DR severity per modified Davis staging · 45-degree field of view · nonmydriatic · CFP
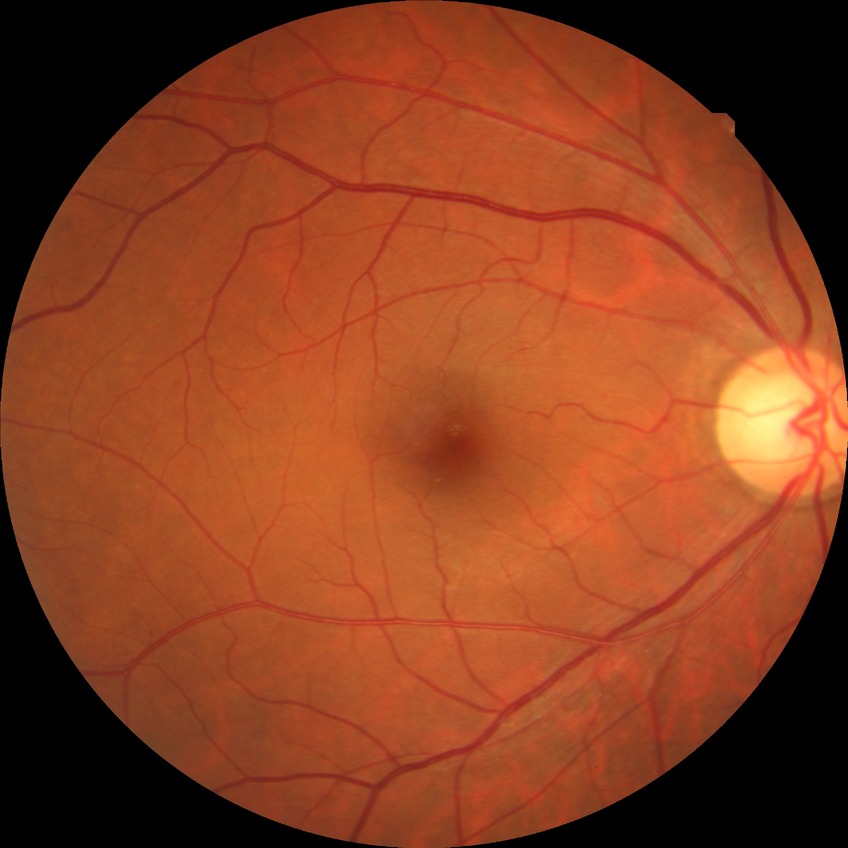 Diabetic retinopathy severity: no diabetic retinopathy.